Camera: NIDEK AFC-230, without pupil dilation:
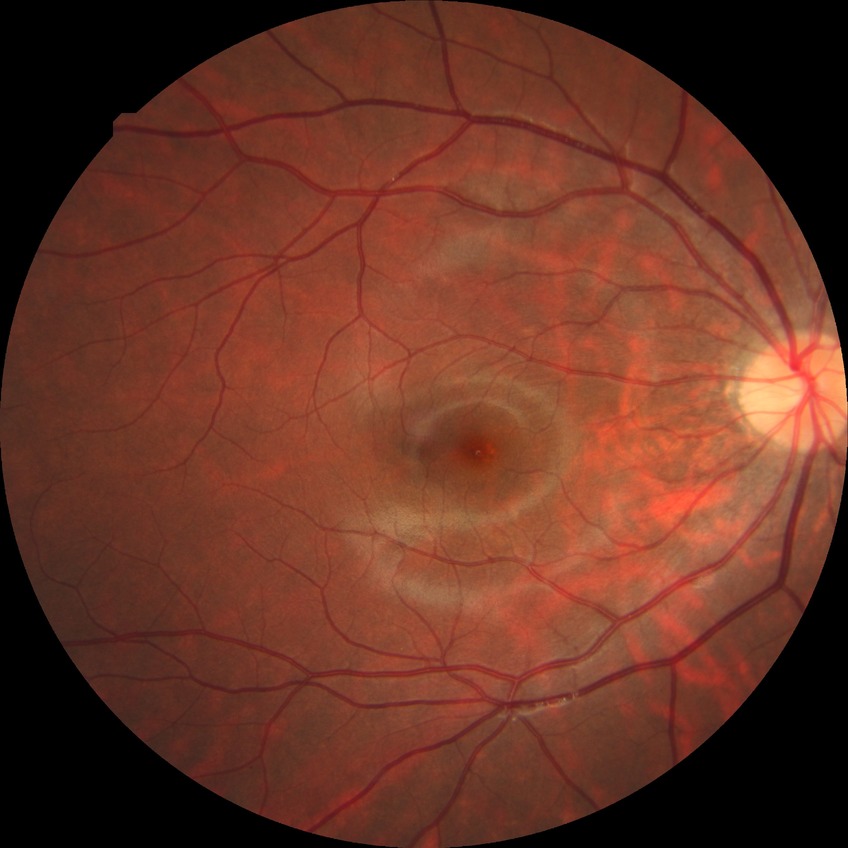

davis_grade: no diabetic retinopathy